Wide-field fundus photograph from neonatal ROP screening:
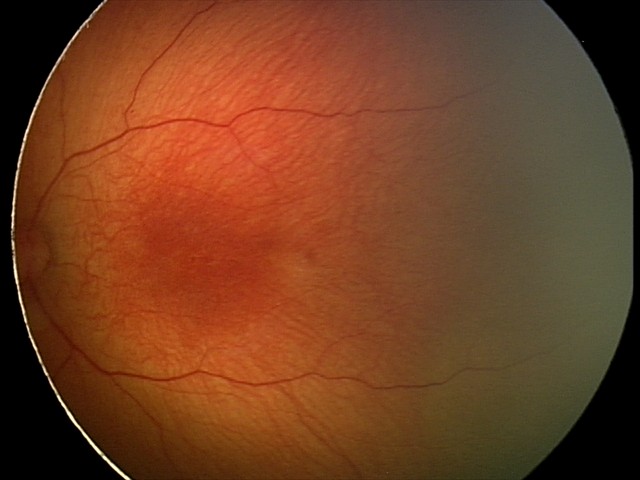

Screening examination diagnosed as physiological.